Color fundus image, 50° FOV, captured on a Topcon TRC-50DX fundus camera, field includes the optic disc and macula — 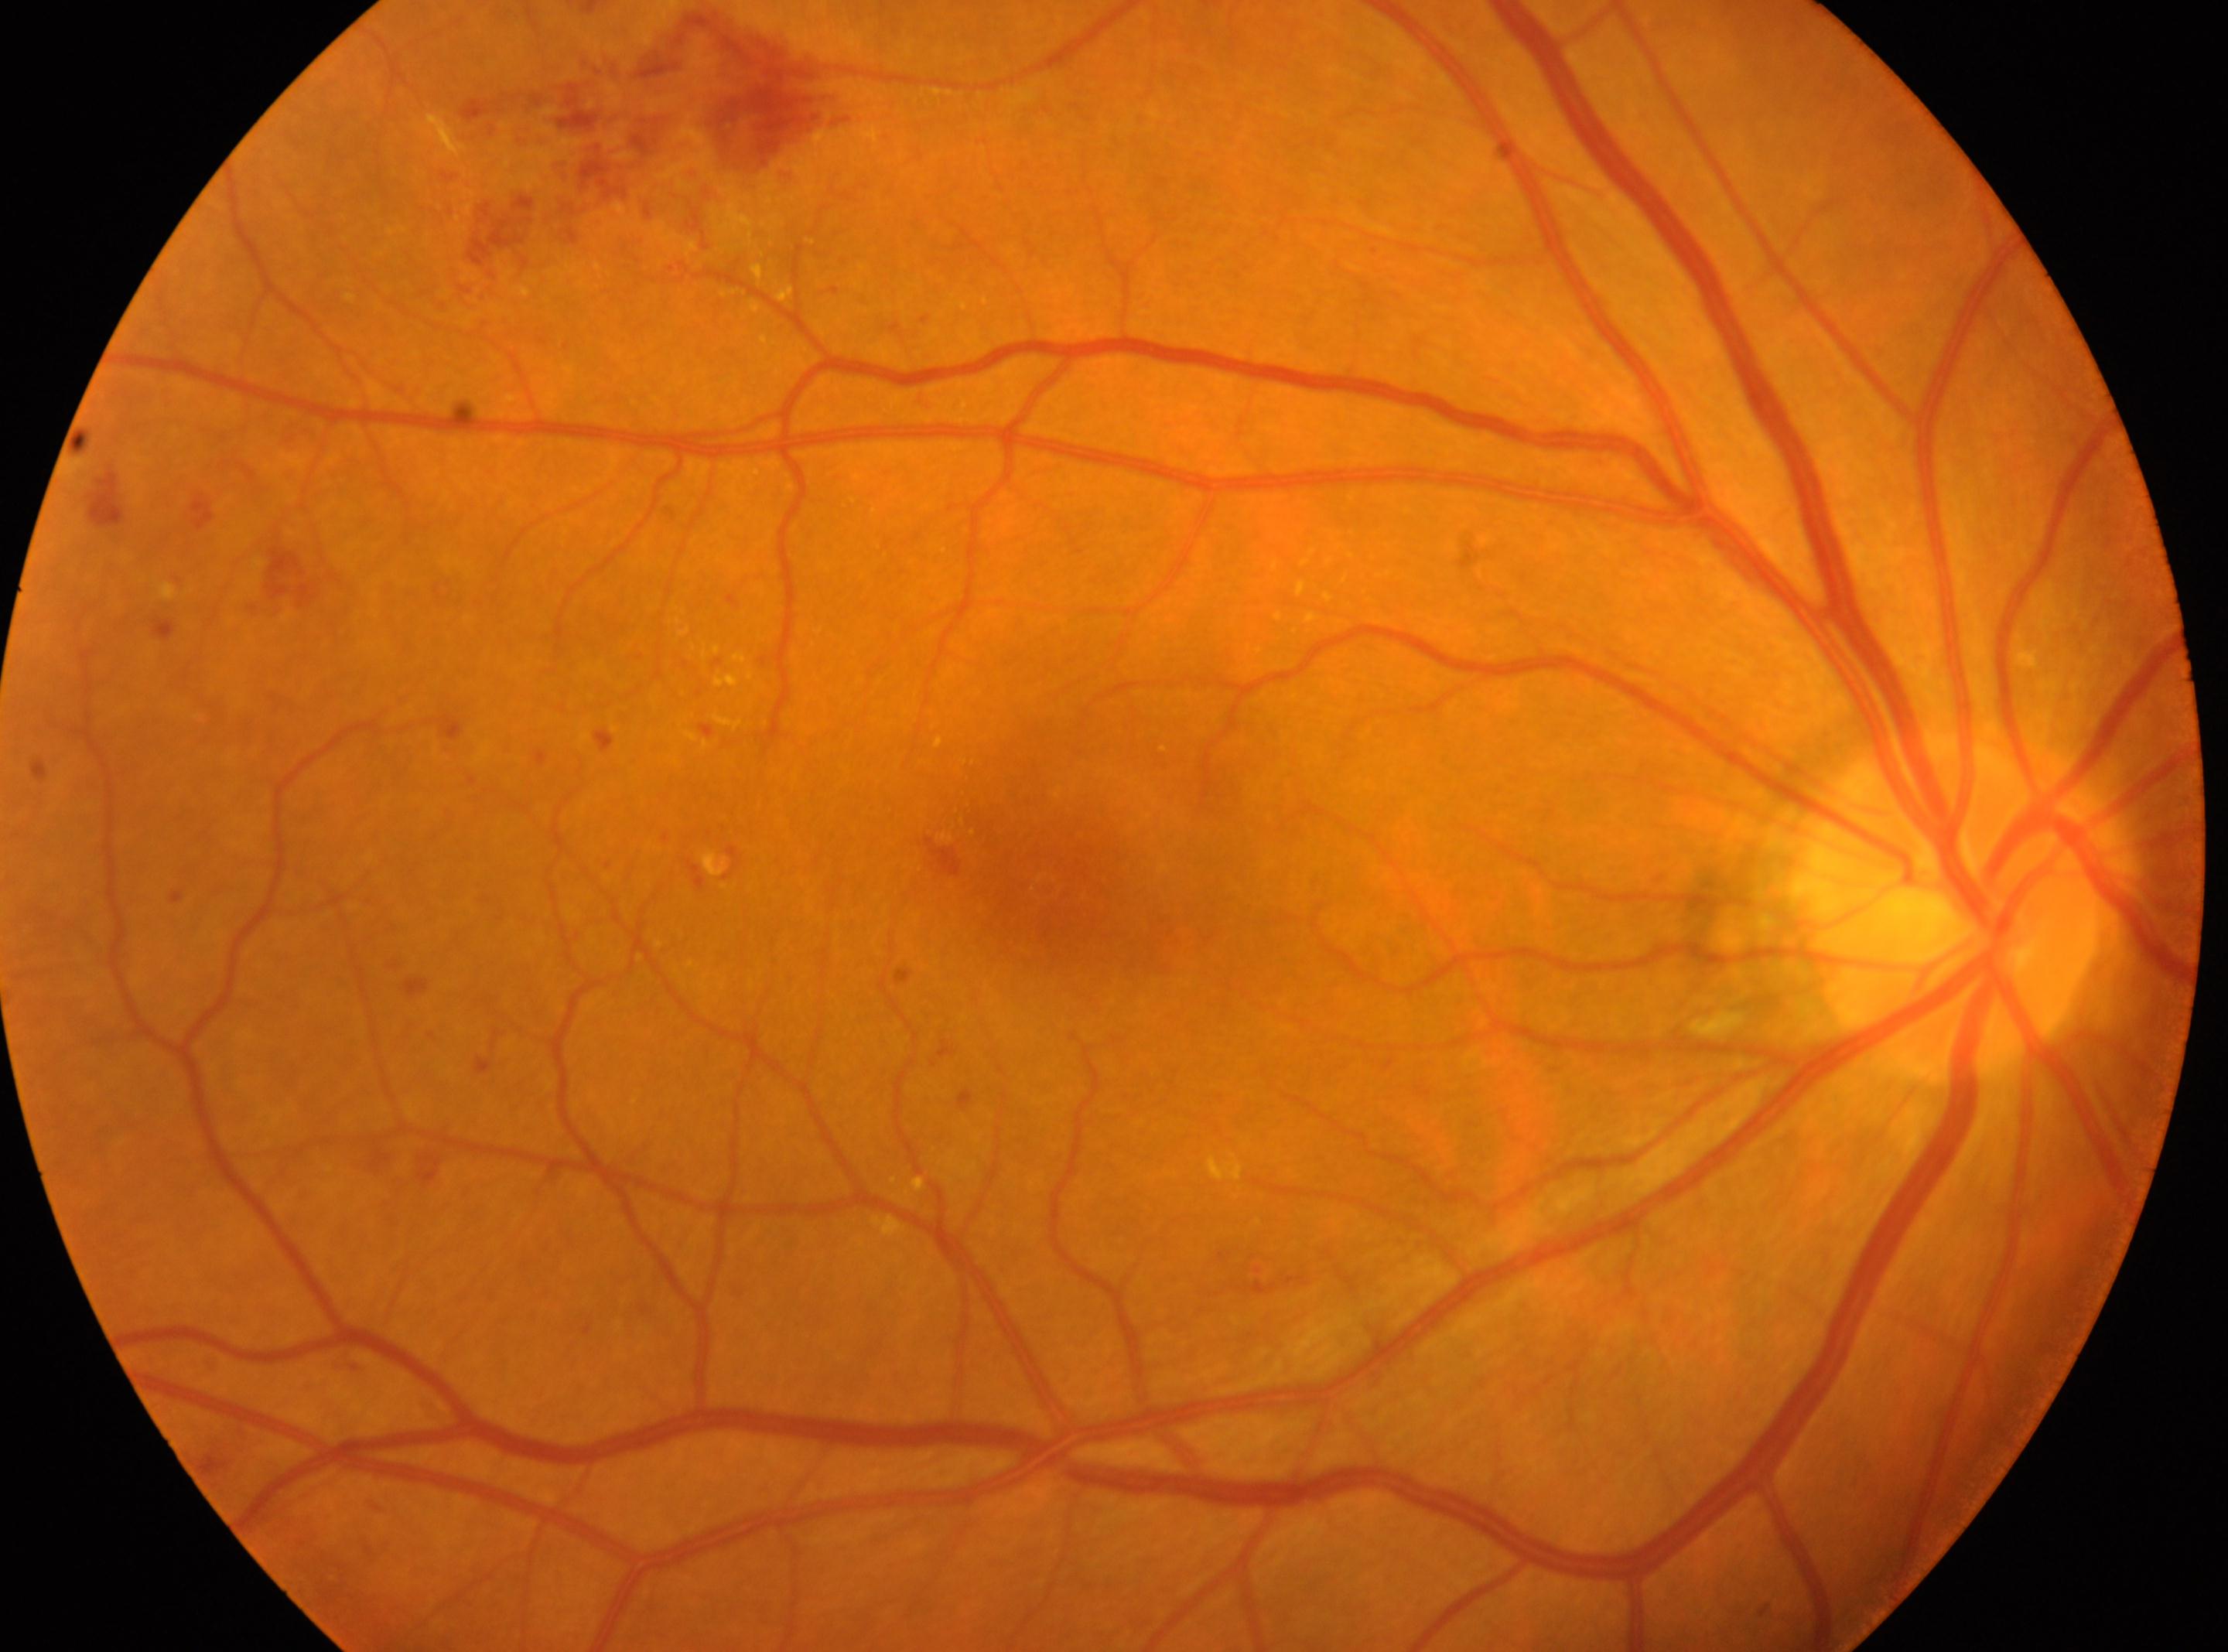
non-proliferative diabetic retinopathy | macular center: (x=1052, y=863) | OD | diabetic retinopathy (DR): grade 2 | optic disc center: (x=1951, y=906).